Phoenix ICON wide-field infant fundus image; acquired on the Phoenix ICON
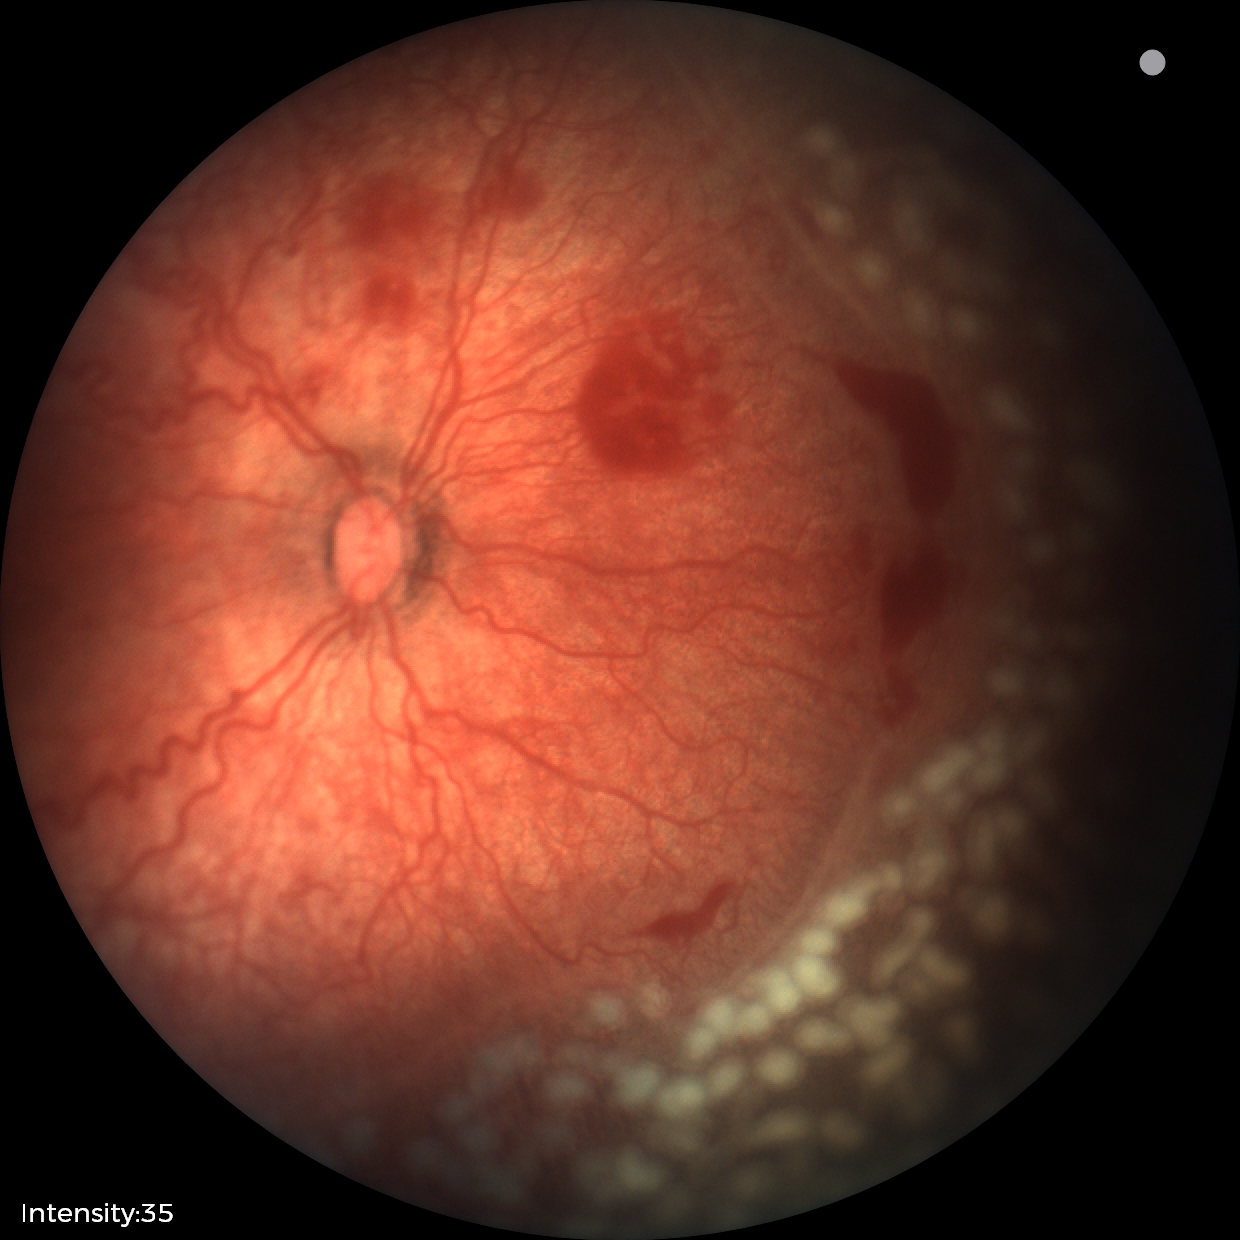

Plus disease was diagnosed. Series diagnosed as retinopathy of prematurity (ROP) stage 2 — ridge with height and width at the demarcation line.